45-degree field of view; acquired with a NIDEK AFC-230; nonmydriatic fundus photograph; modified Davis grading
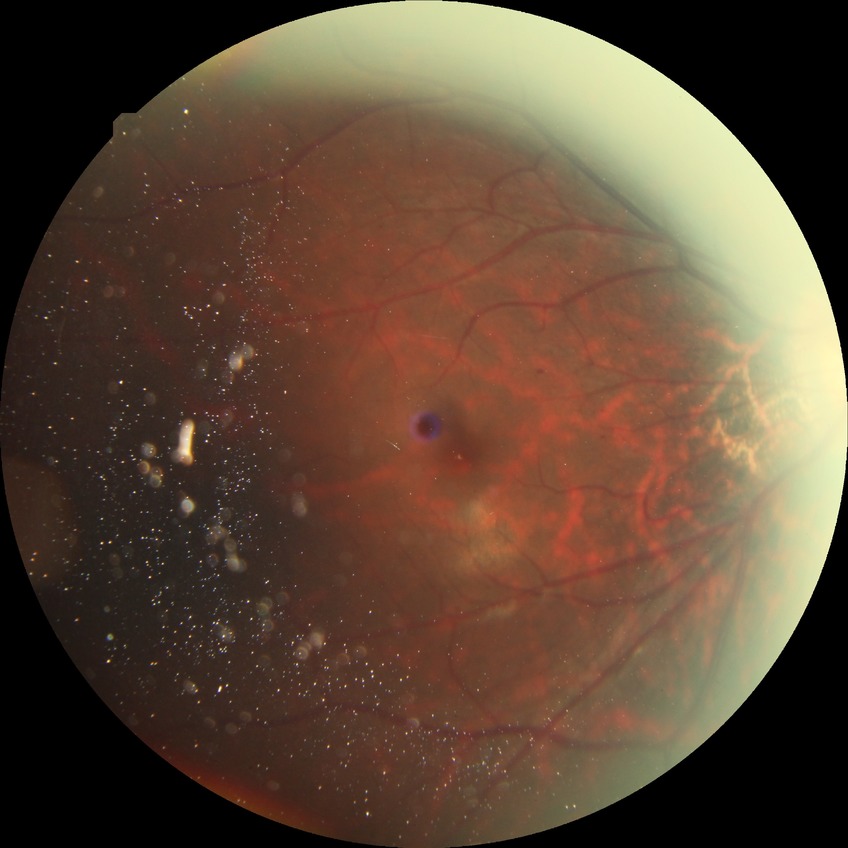 Diabetic retinopathy stage is simple diabetic retinopathy.